Acquired with a NIDEK AFC-230; FOV: 45 degrees
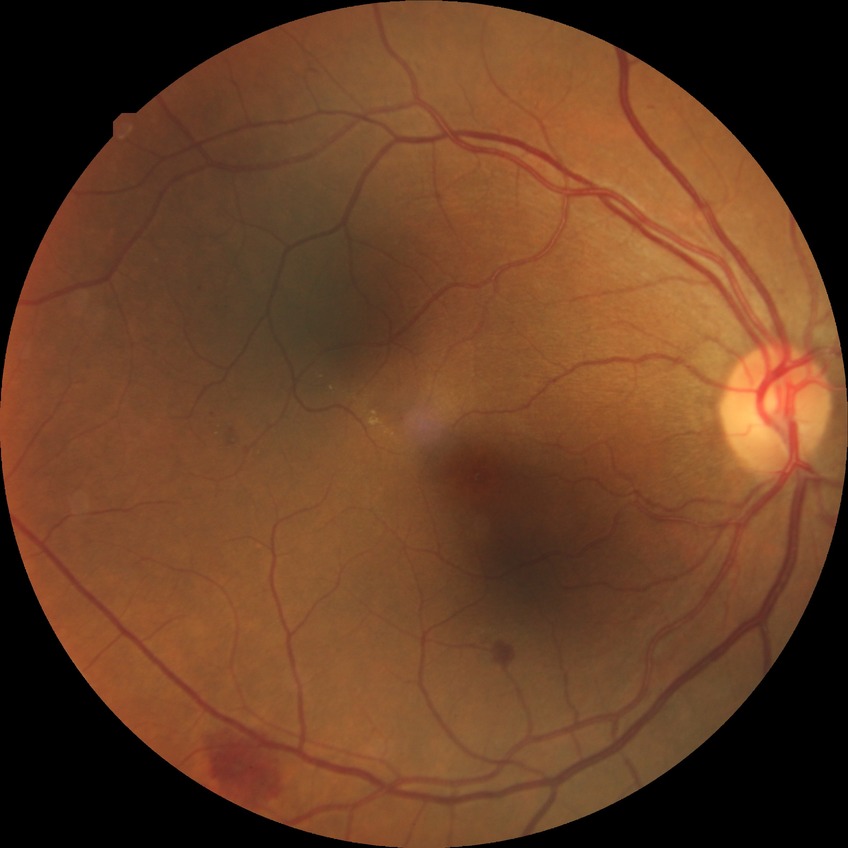

DR class: non-proliferative diabetic retinopathy. Davis grade: SDR.